Wide-field fundus photograph of an infant · 640 x 480 pixels — 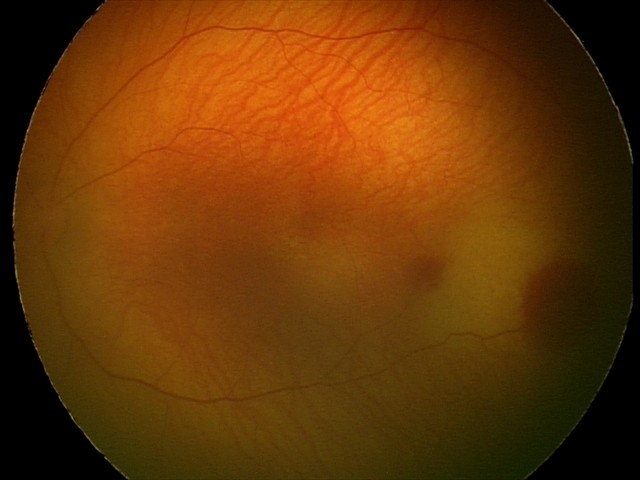 Assessment: retinal hemorrhages.